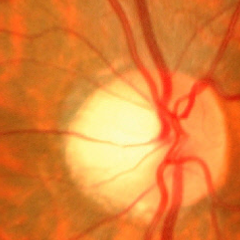 Severe glaucomatous damage.